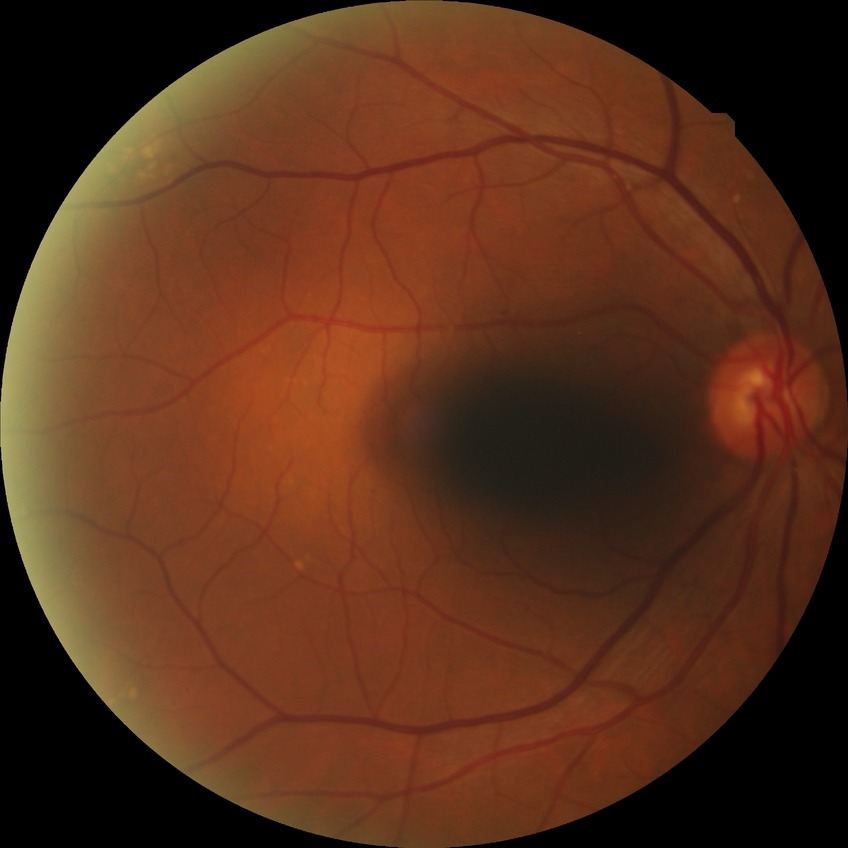 Findings:
- DR impression — negative for DR
- modified Davis grade — NDR